Fundus photo · diabetic retinopathy graded by the modified Davis classification · acquired with a NIDEK AFC-230 · nonmydriatic · image size 848x848 — 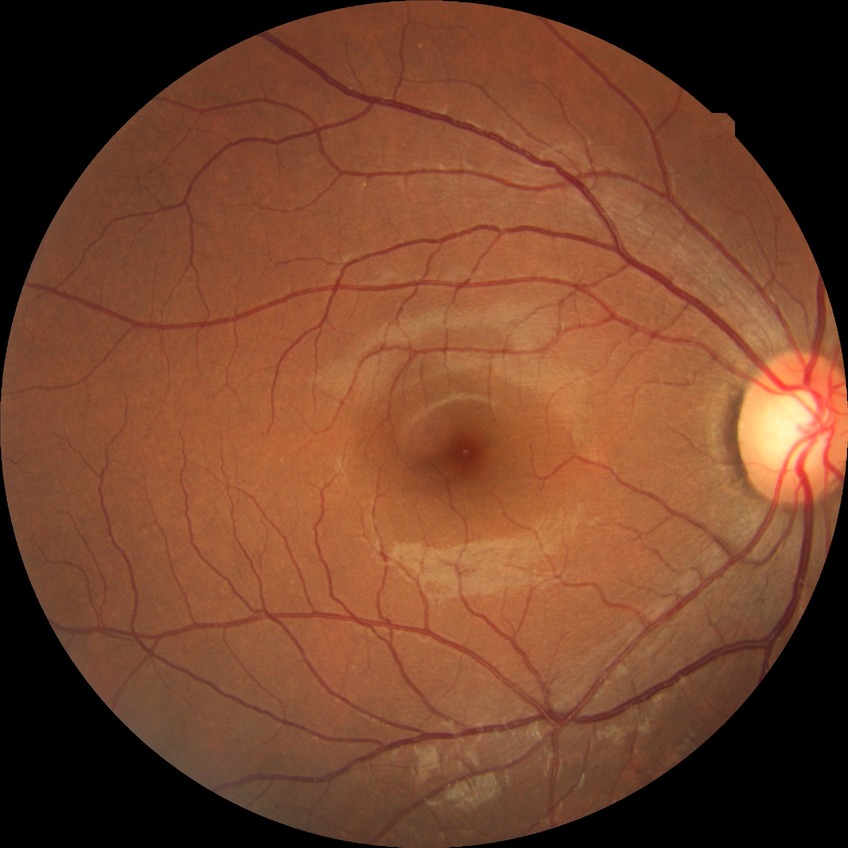
Diabetic retinopathy (DR): NDR (no diabetic retinopathy).